Optic disc region crop — 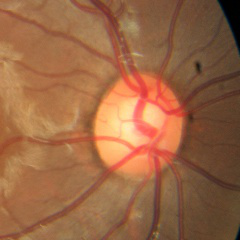
Glaucoma stage = no evidence of glaucoma.